Davis DR grading — 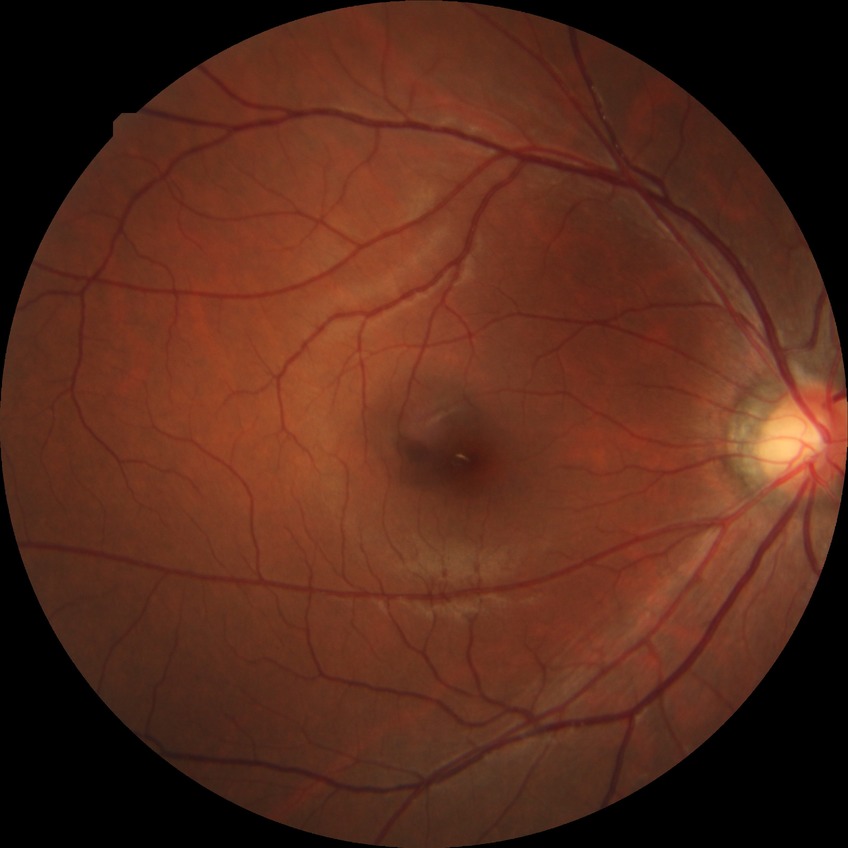

diabetic retinopathy grade = no diabetic retinopathy.